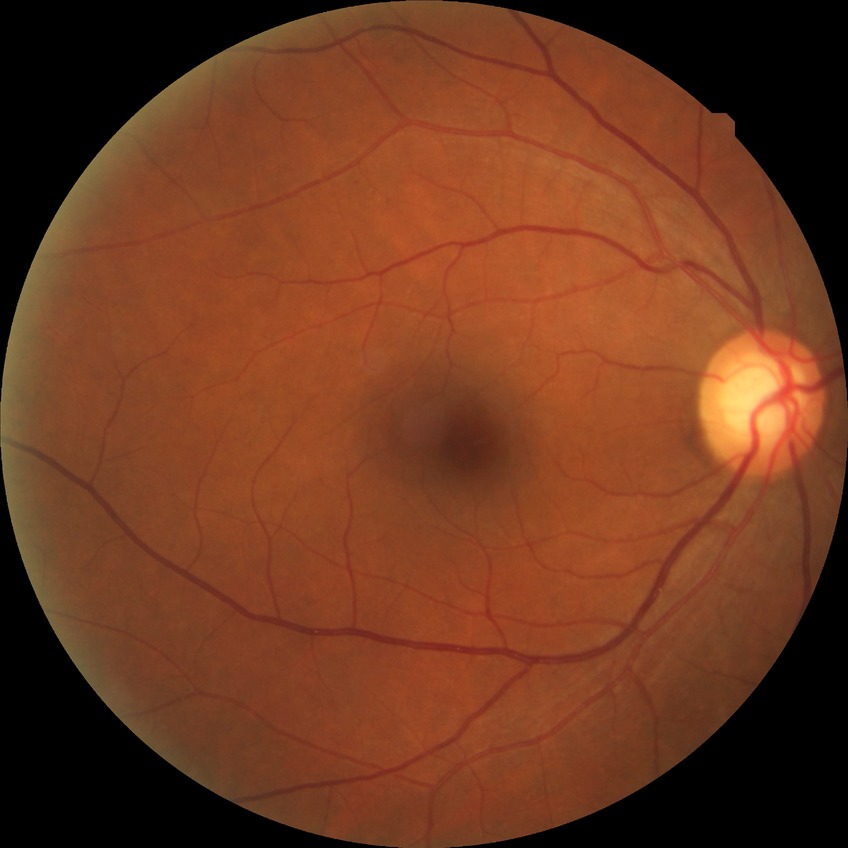
Davis DR grade is SDR.